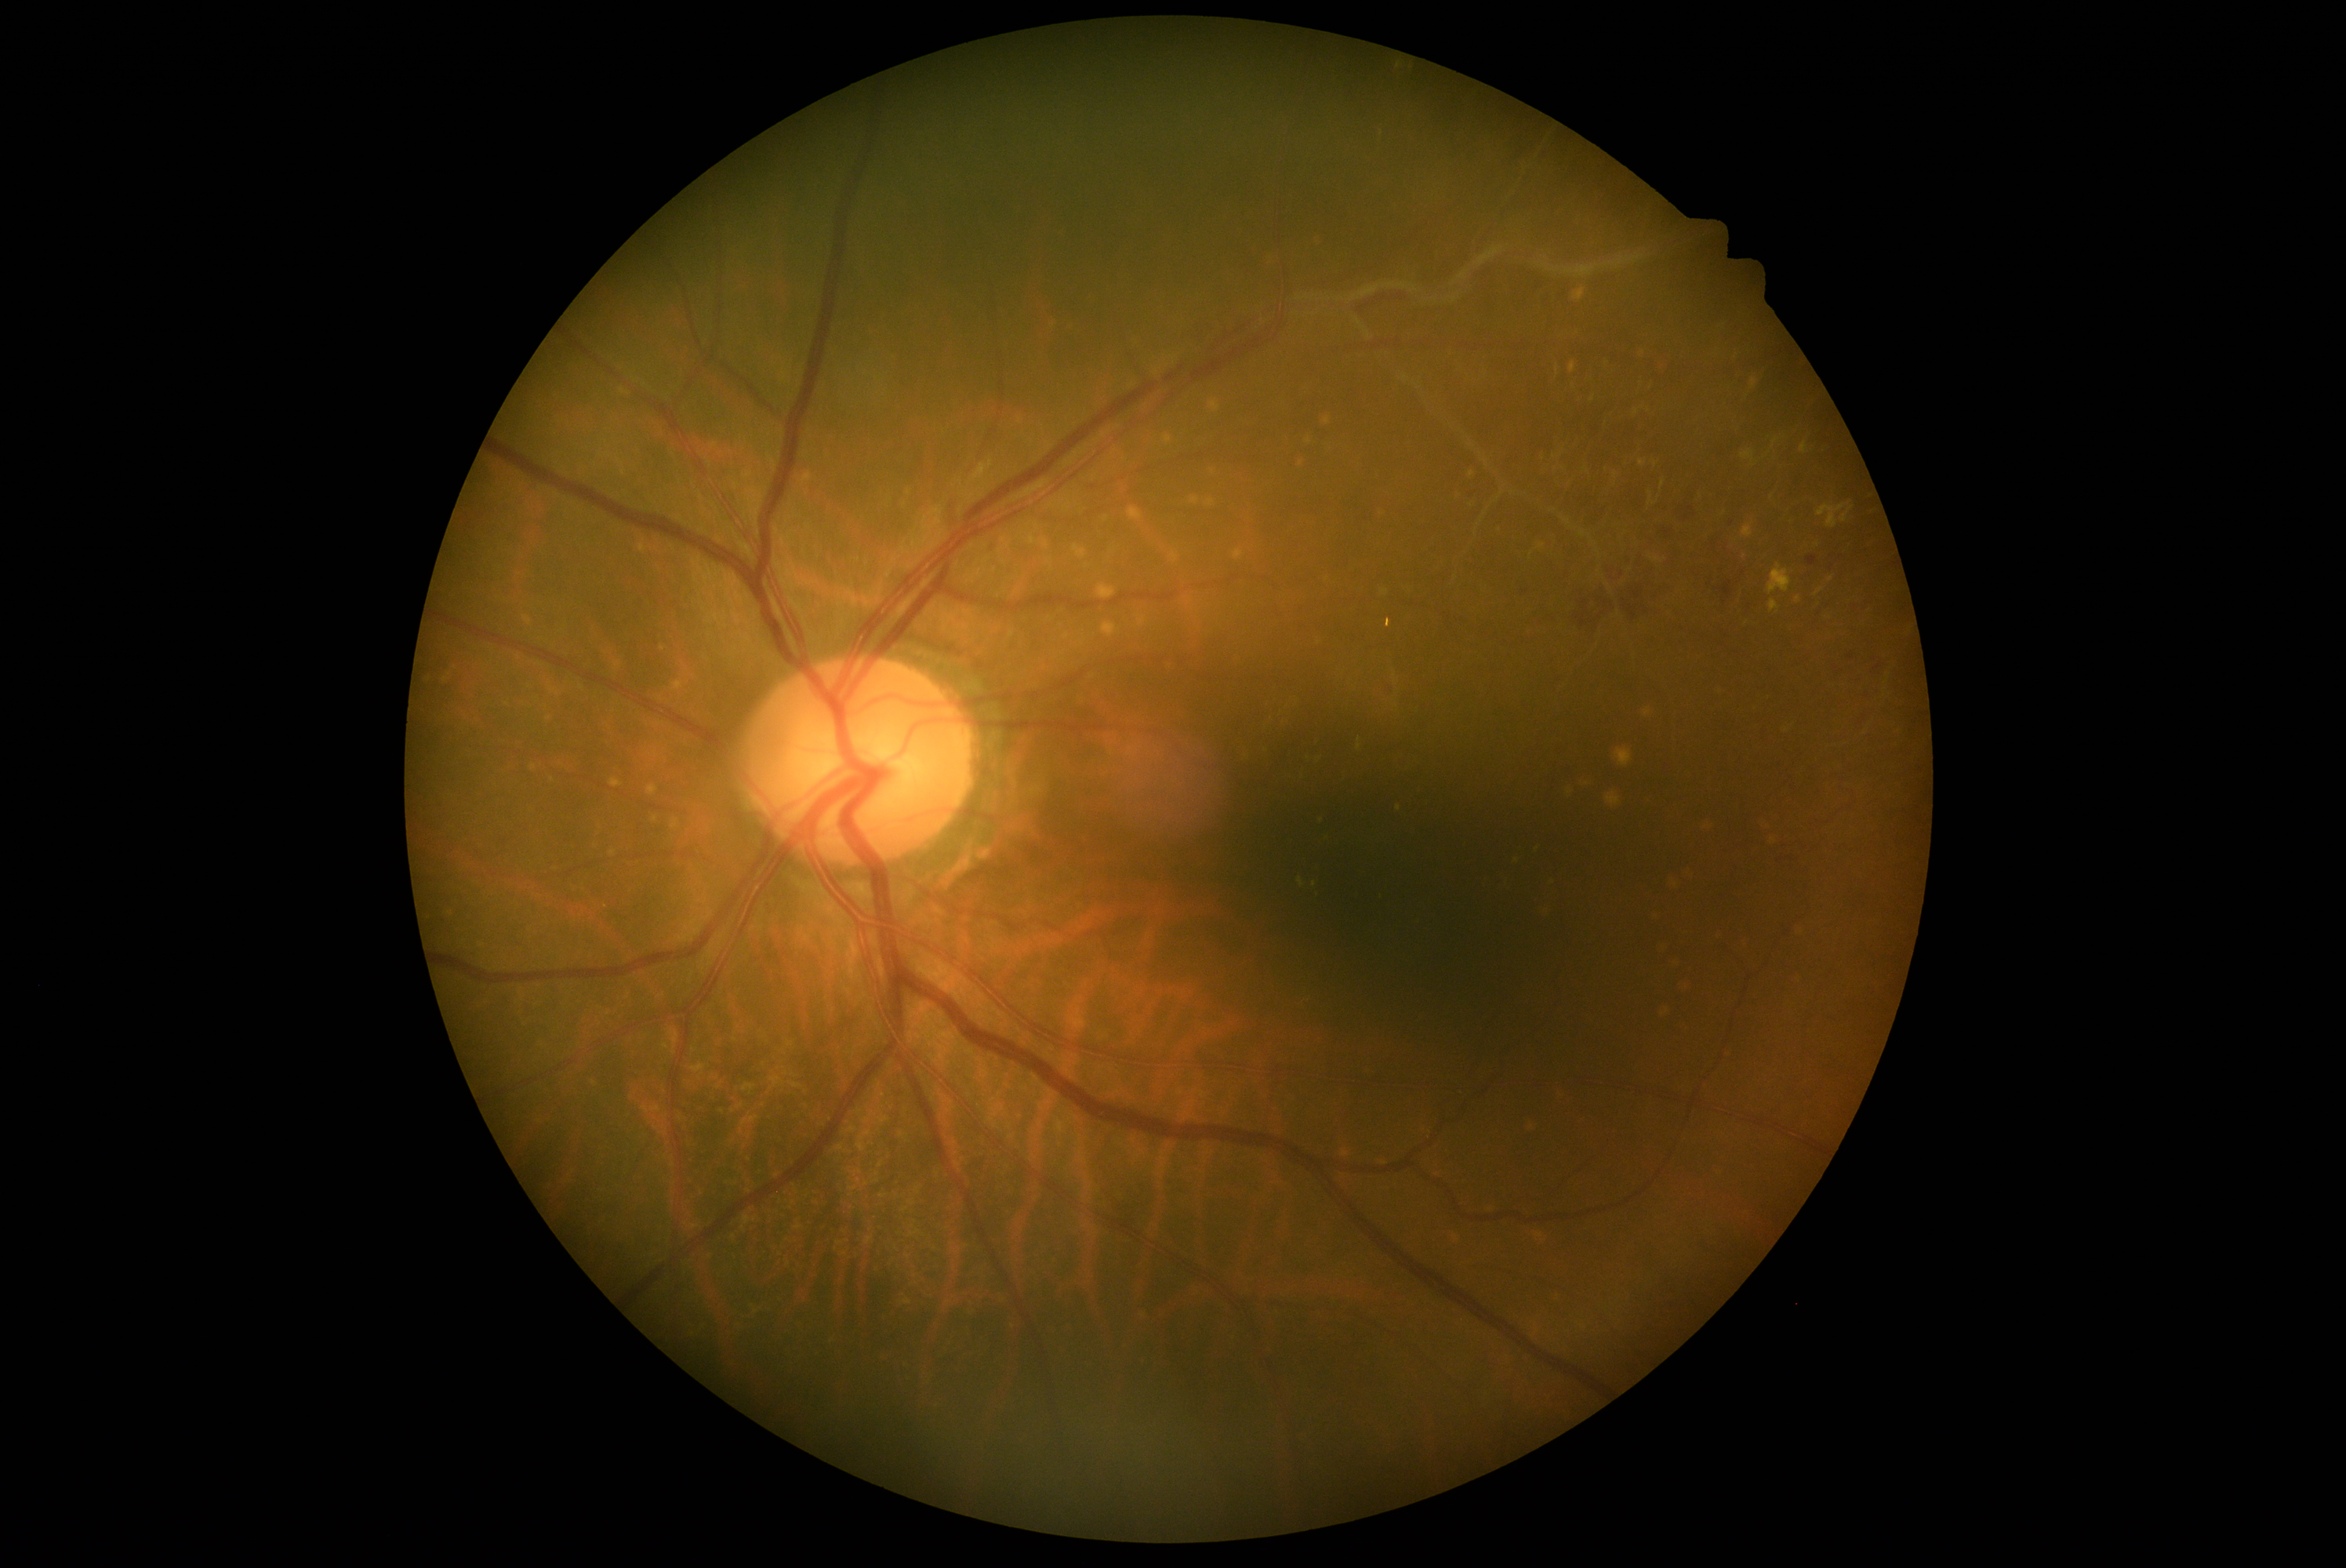
Diabetic retinopathy (DR) is grade 2.